Davis DR grading:
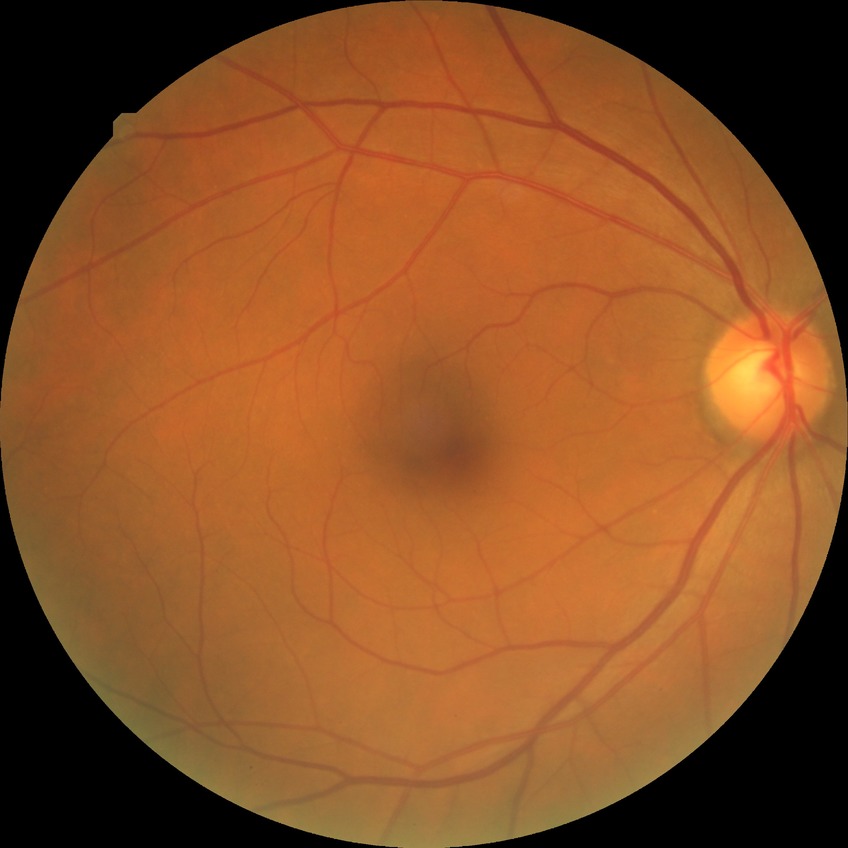 Diabetic retinopathy (DR): no diabetic retinopathy (NDR).